45-degree field of view:
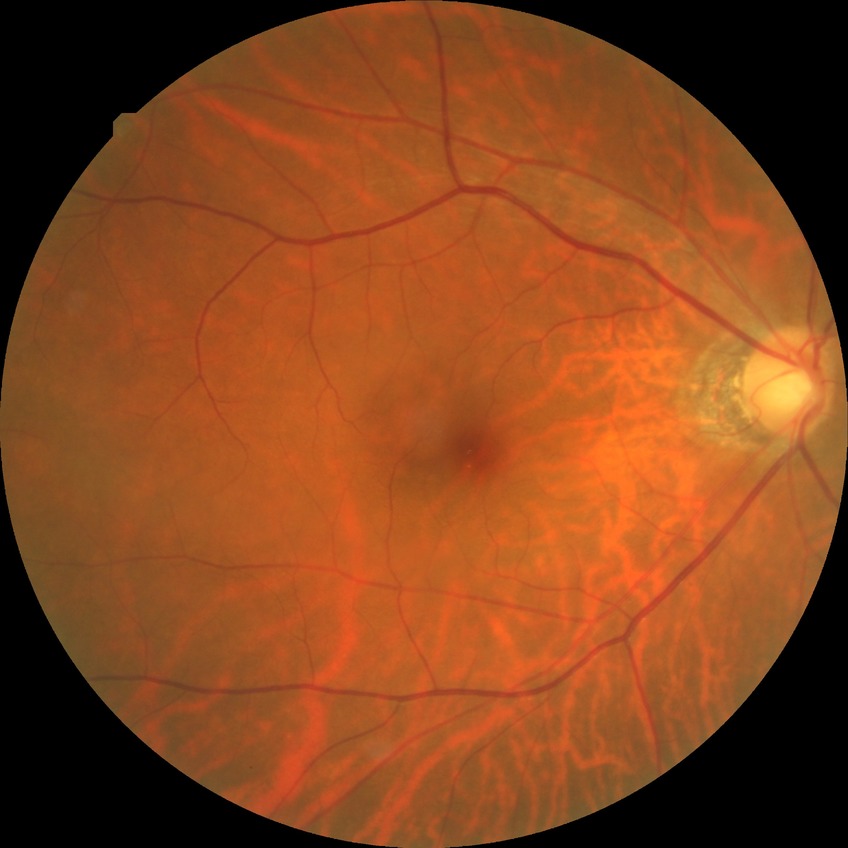

modified Davis classification = no diabetic retinopathy